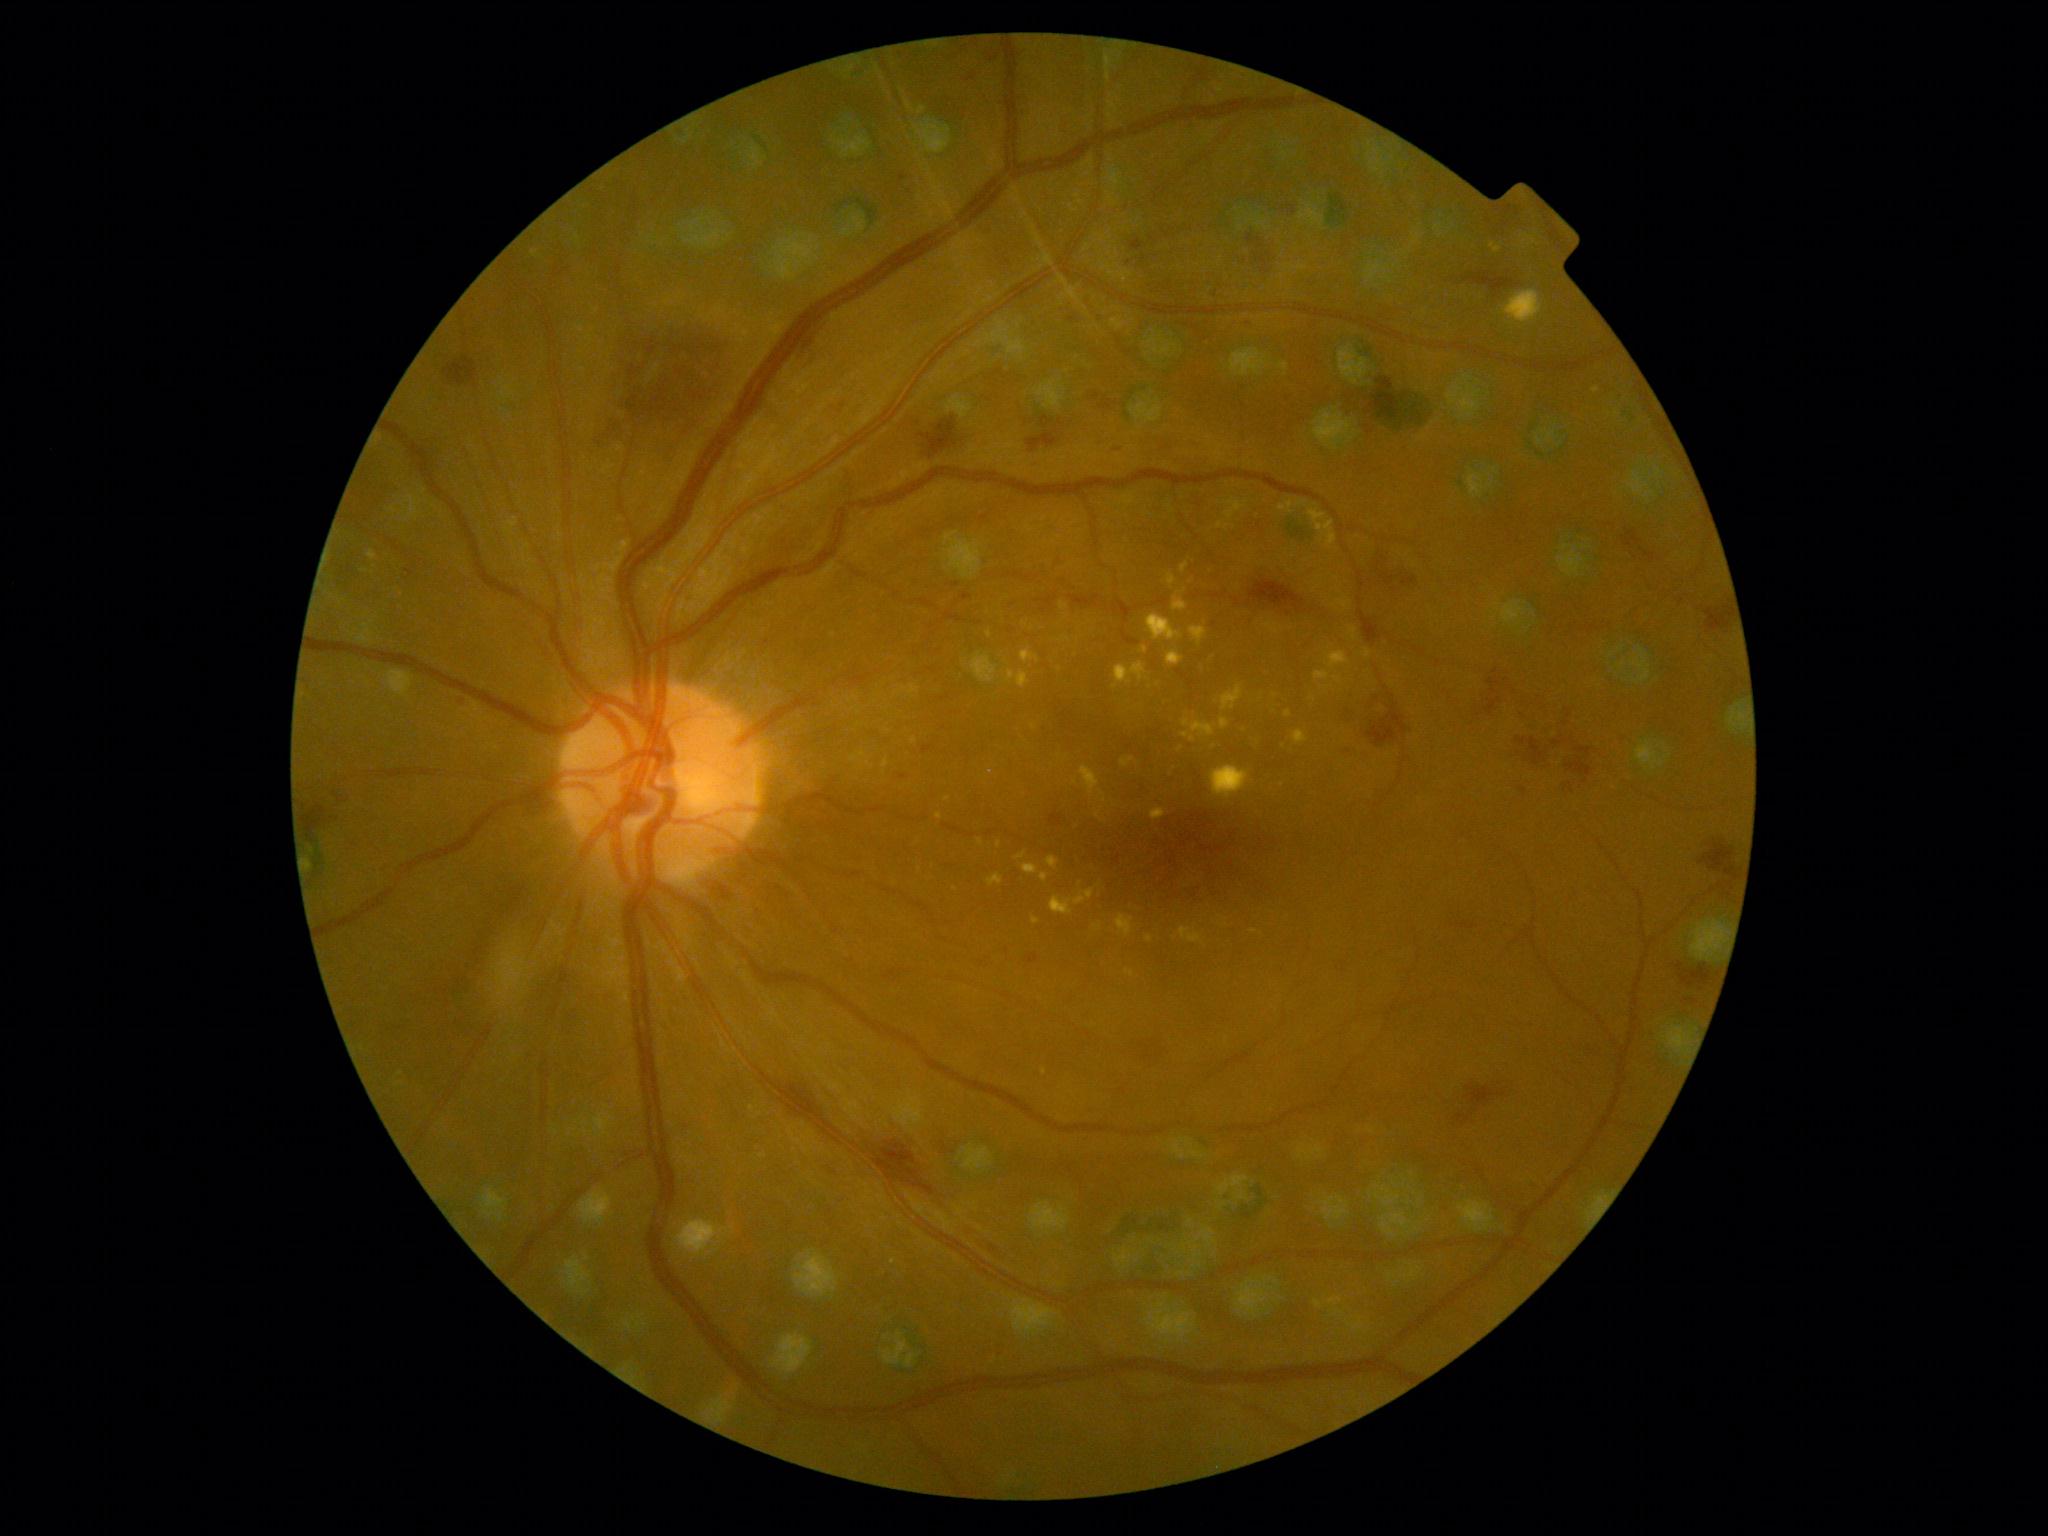

Diabetic retinopathy (DR) is 2
A subset of detected lesions:
- hemorrhages (HEs) (partial): (1463, 272, 1516, 298) | (1566, 757, 1593, 778) | (444, 357, 477, 387) | (953, 1216, 1009, 1261) | (923, 746, 933, 754) | (1109, 444, 1128, 450) | (1509, 689, 1547, 733) | (1360, 611, 1383, 646) | (1676, 962, 1683, 972) | (1341, 749, 1357, 758) | (1347, 709, 1357, 725) | (1641, 548, 1656, 563) | (1050, 813, 1063, 826)
- Small HEs approximately at x=1129 y=263 | x=1686 y=1001 | x=1585 y=782